Retinal fundus photograph. Image size 2346x1568
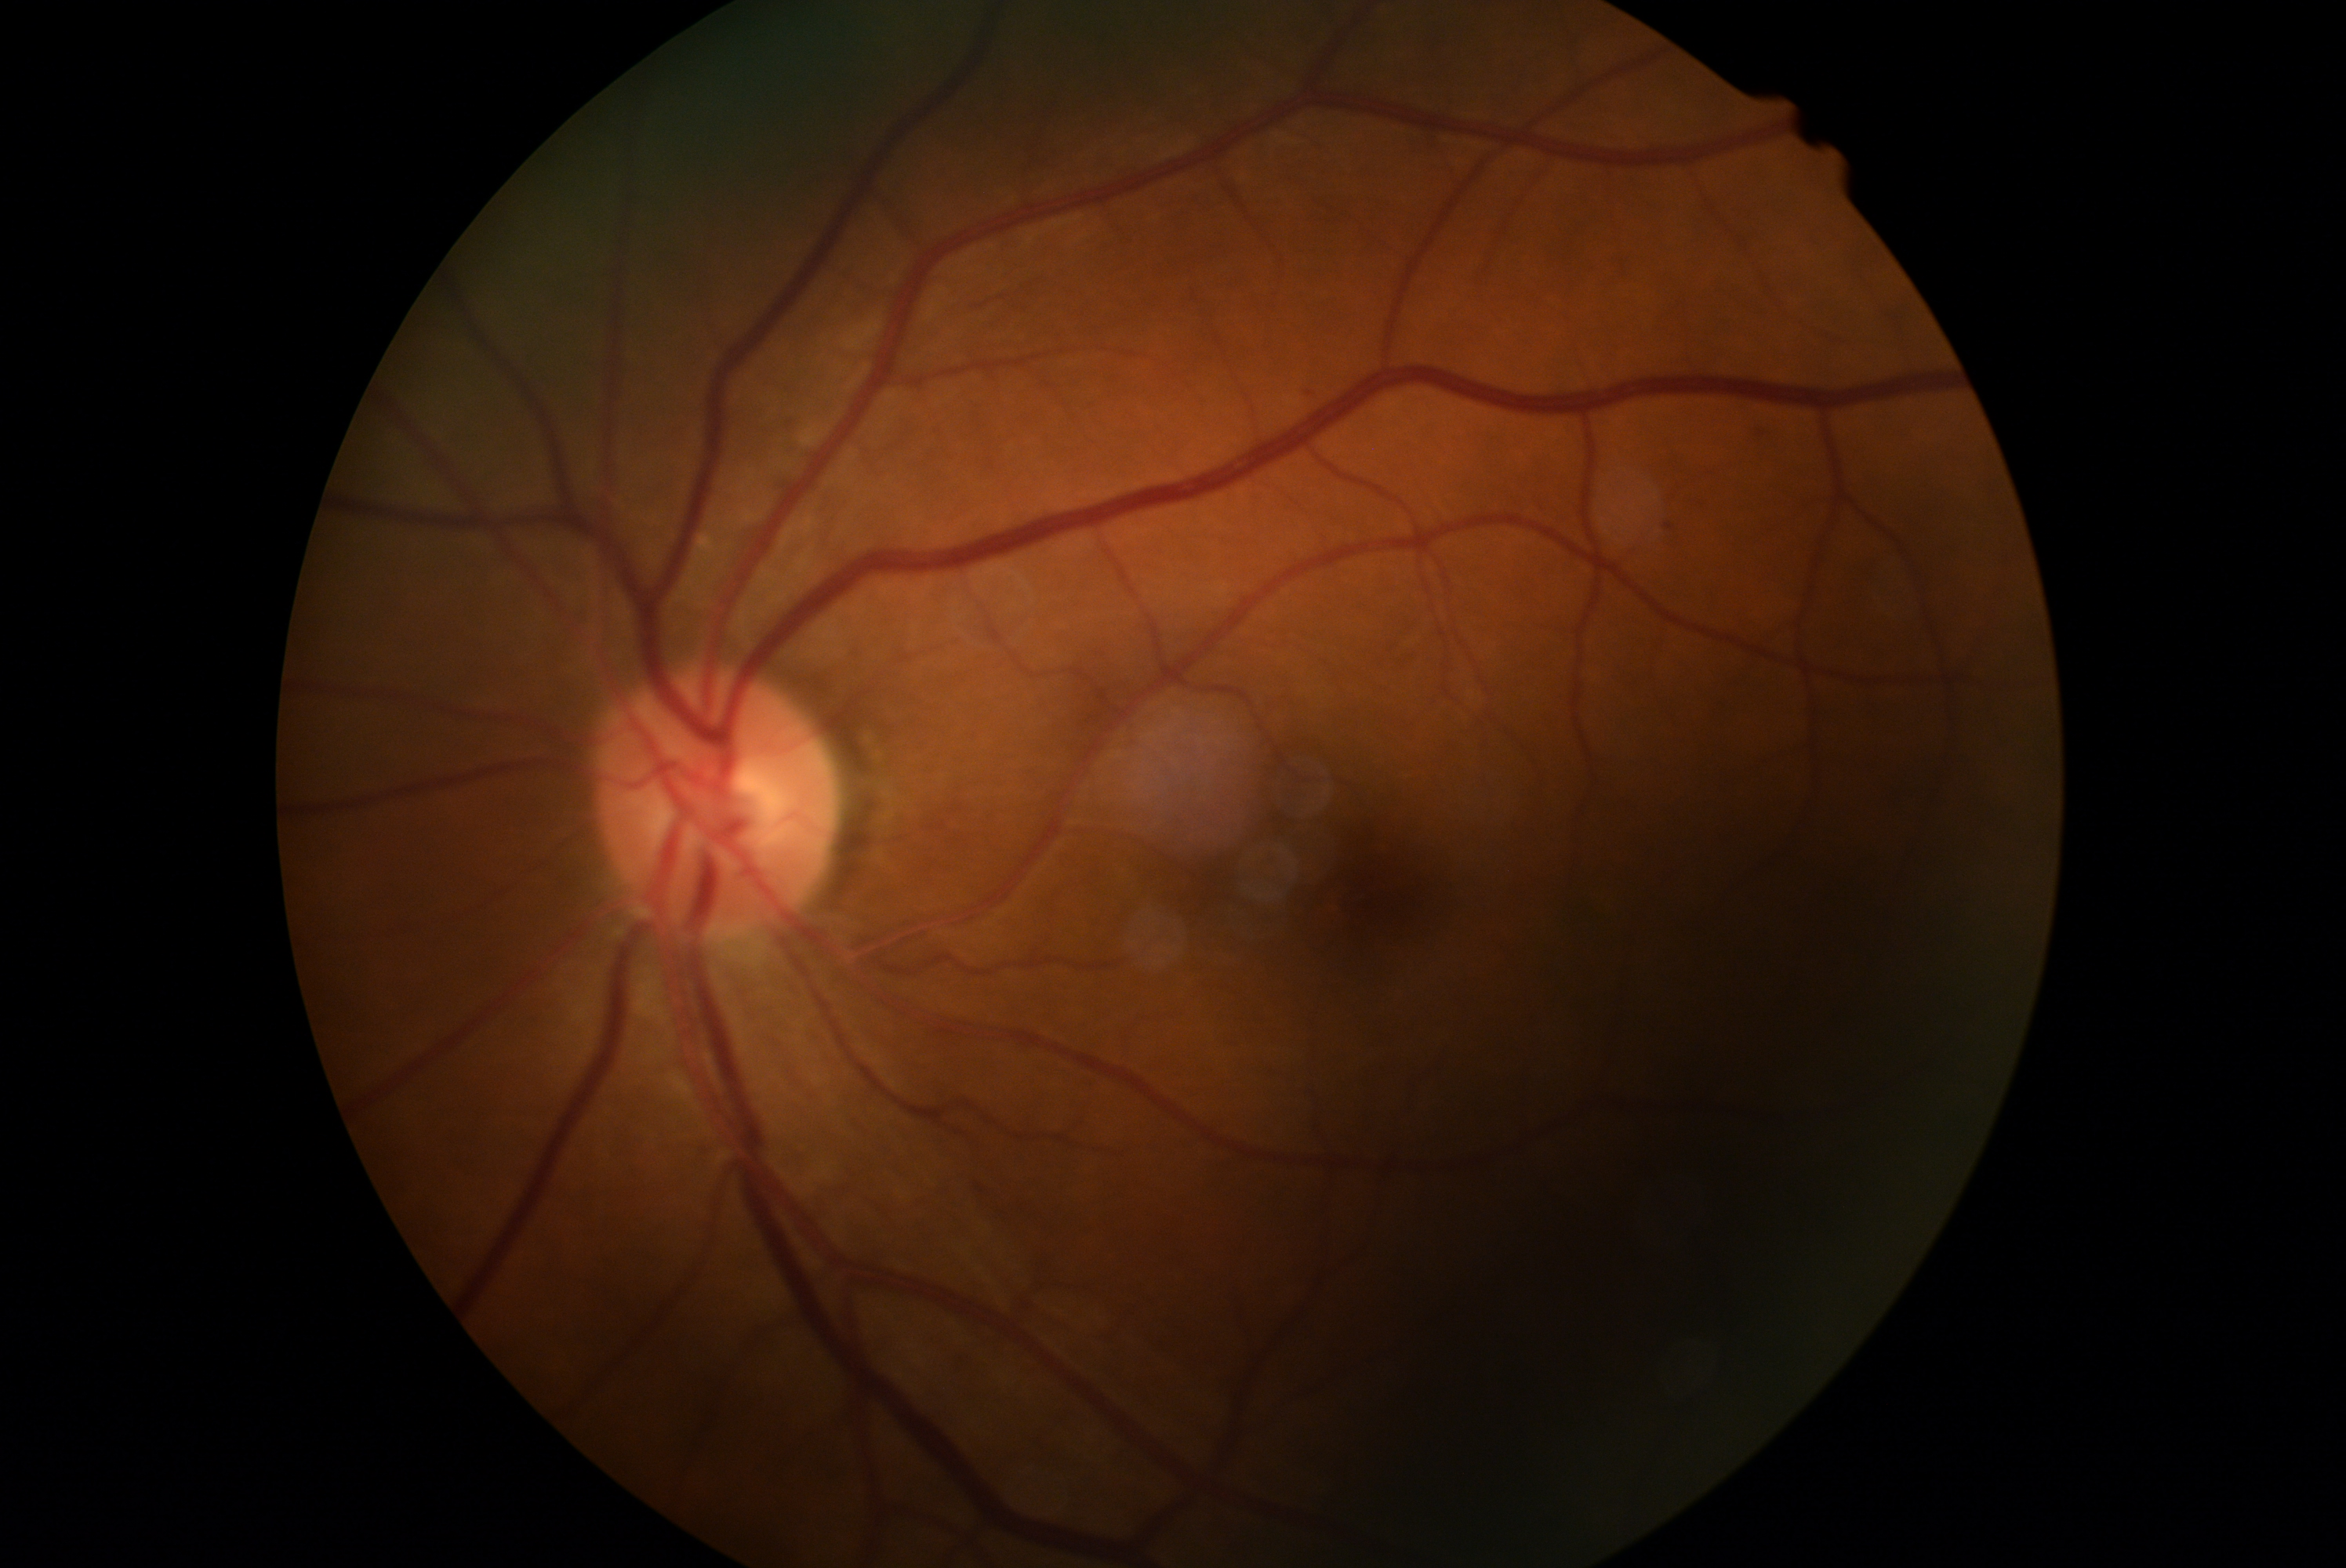

The retinopathy is classified as non-proliferative diabetic retinopathy. DR severity is 1.